Nonmydriatic fundus photograph, modified Davis grading:
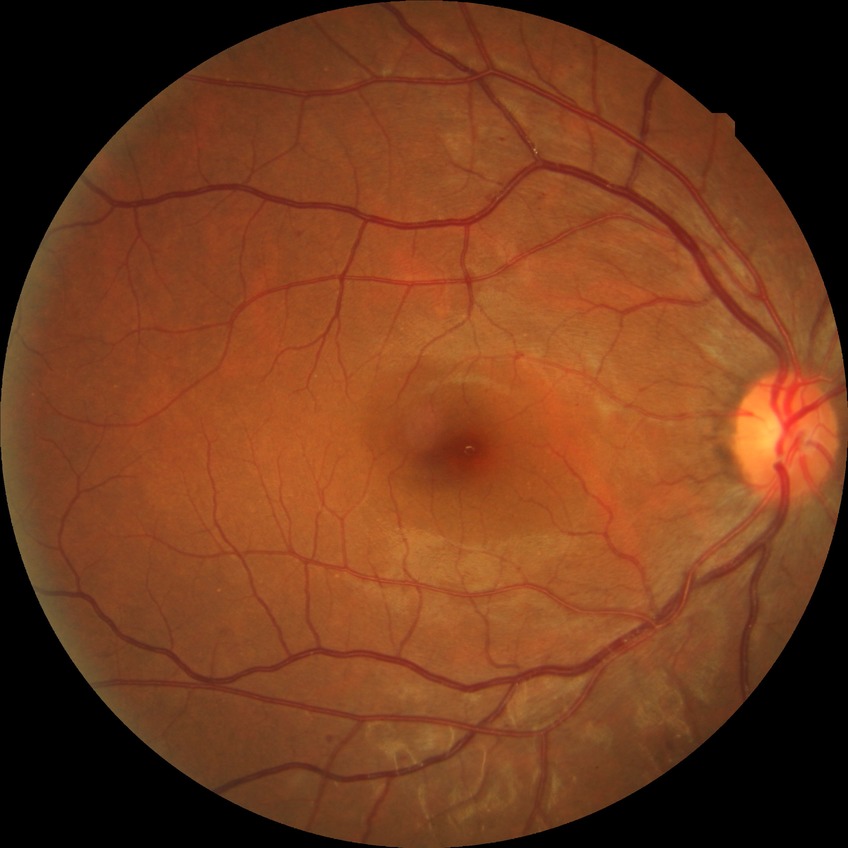

Diabetic retinopathy (DR): SDR (simple diabetic retinopathy).